Wide-field fundus photograph from neonatal ROP screening; 1240 x 1240 pixels: 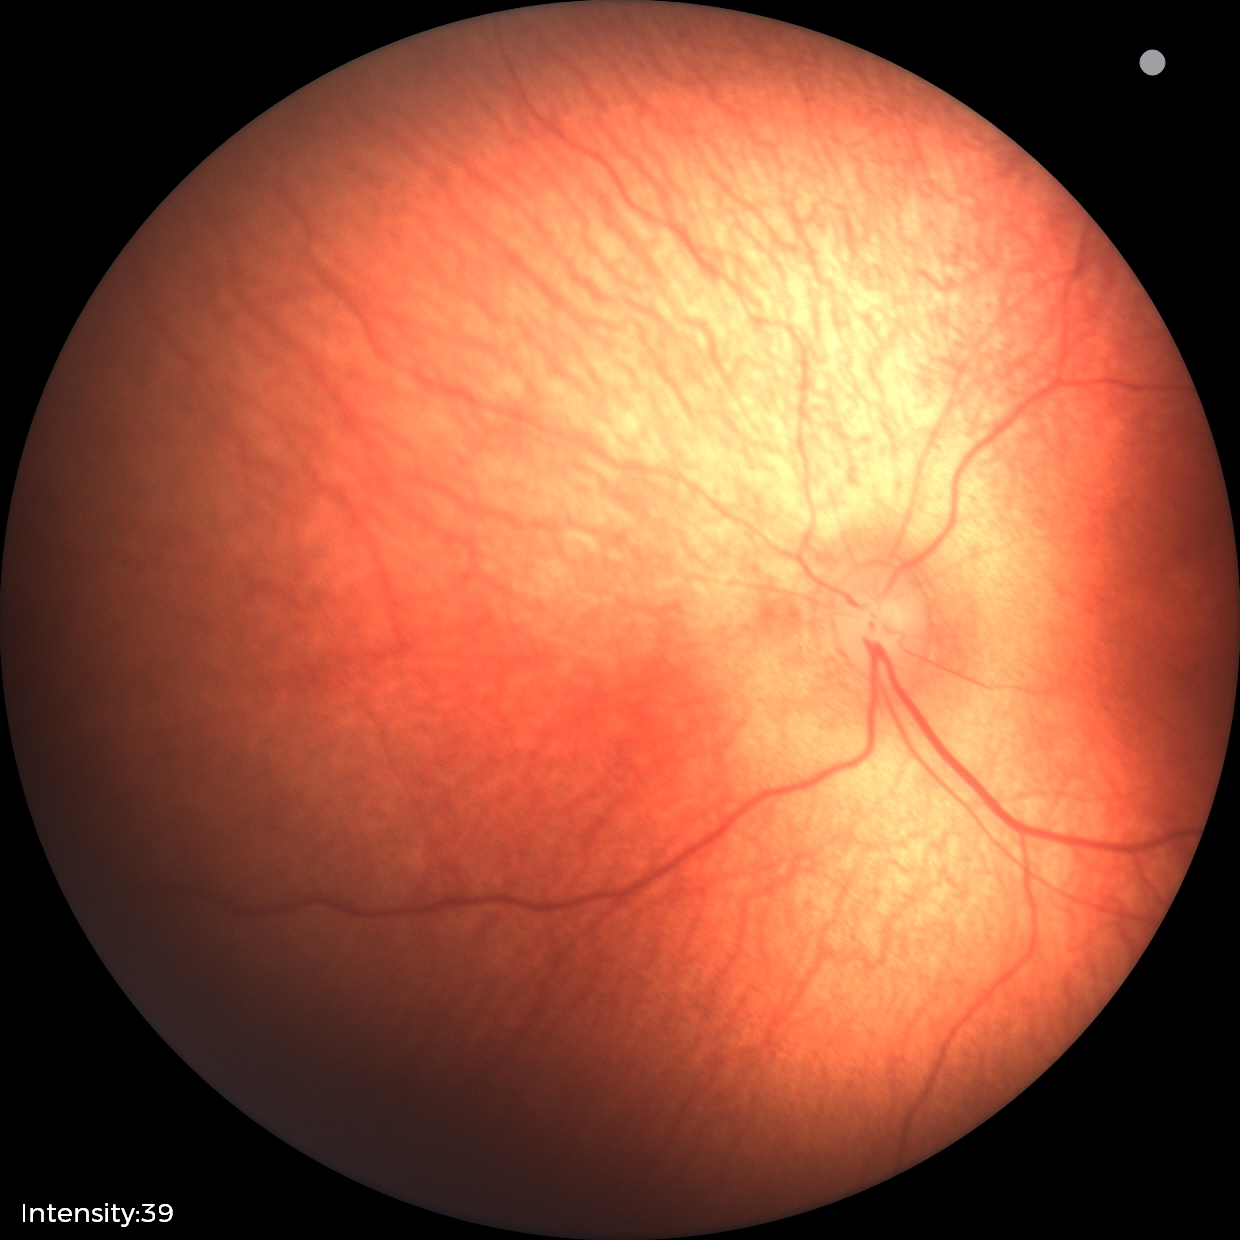
Normal screening examination.